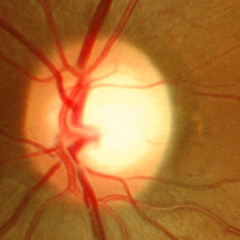
Findings consistent with glaucoma. Impression: early glaucomatous changes.